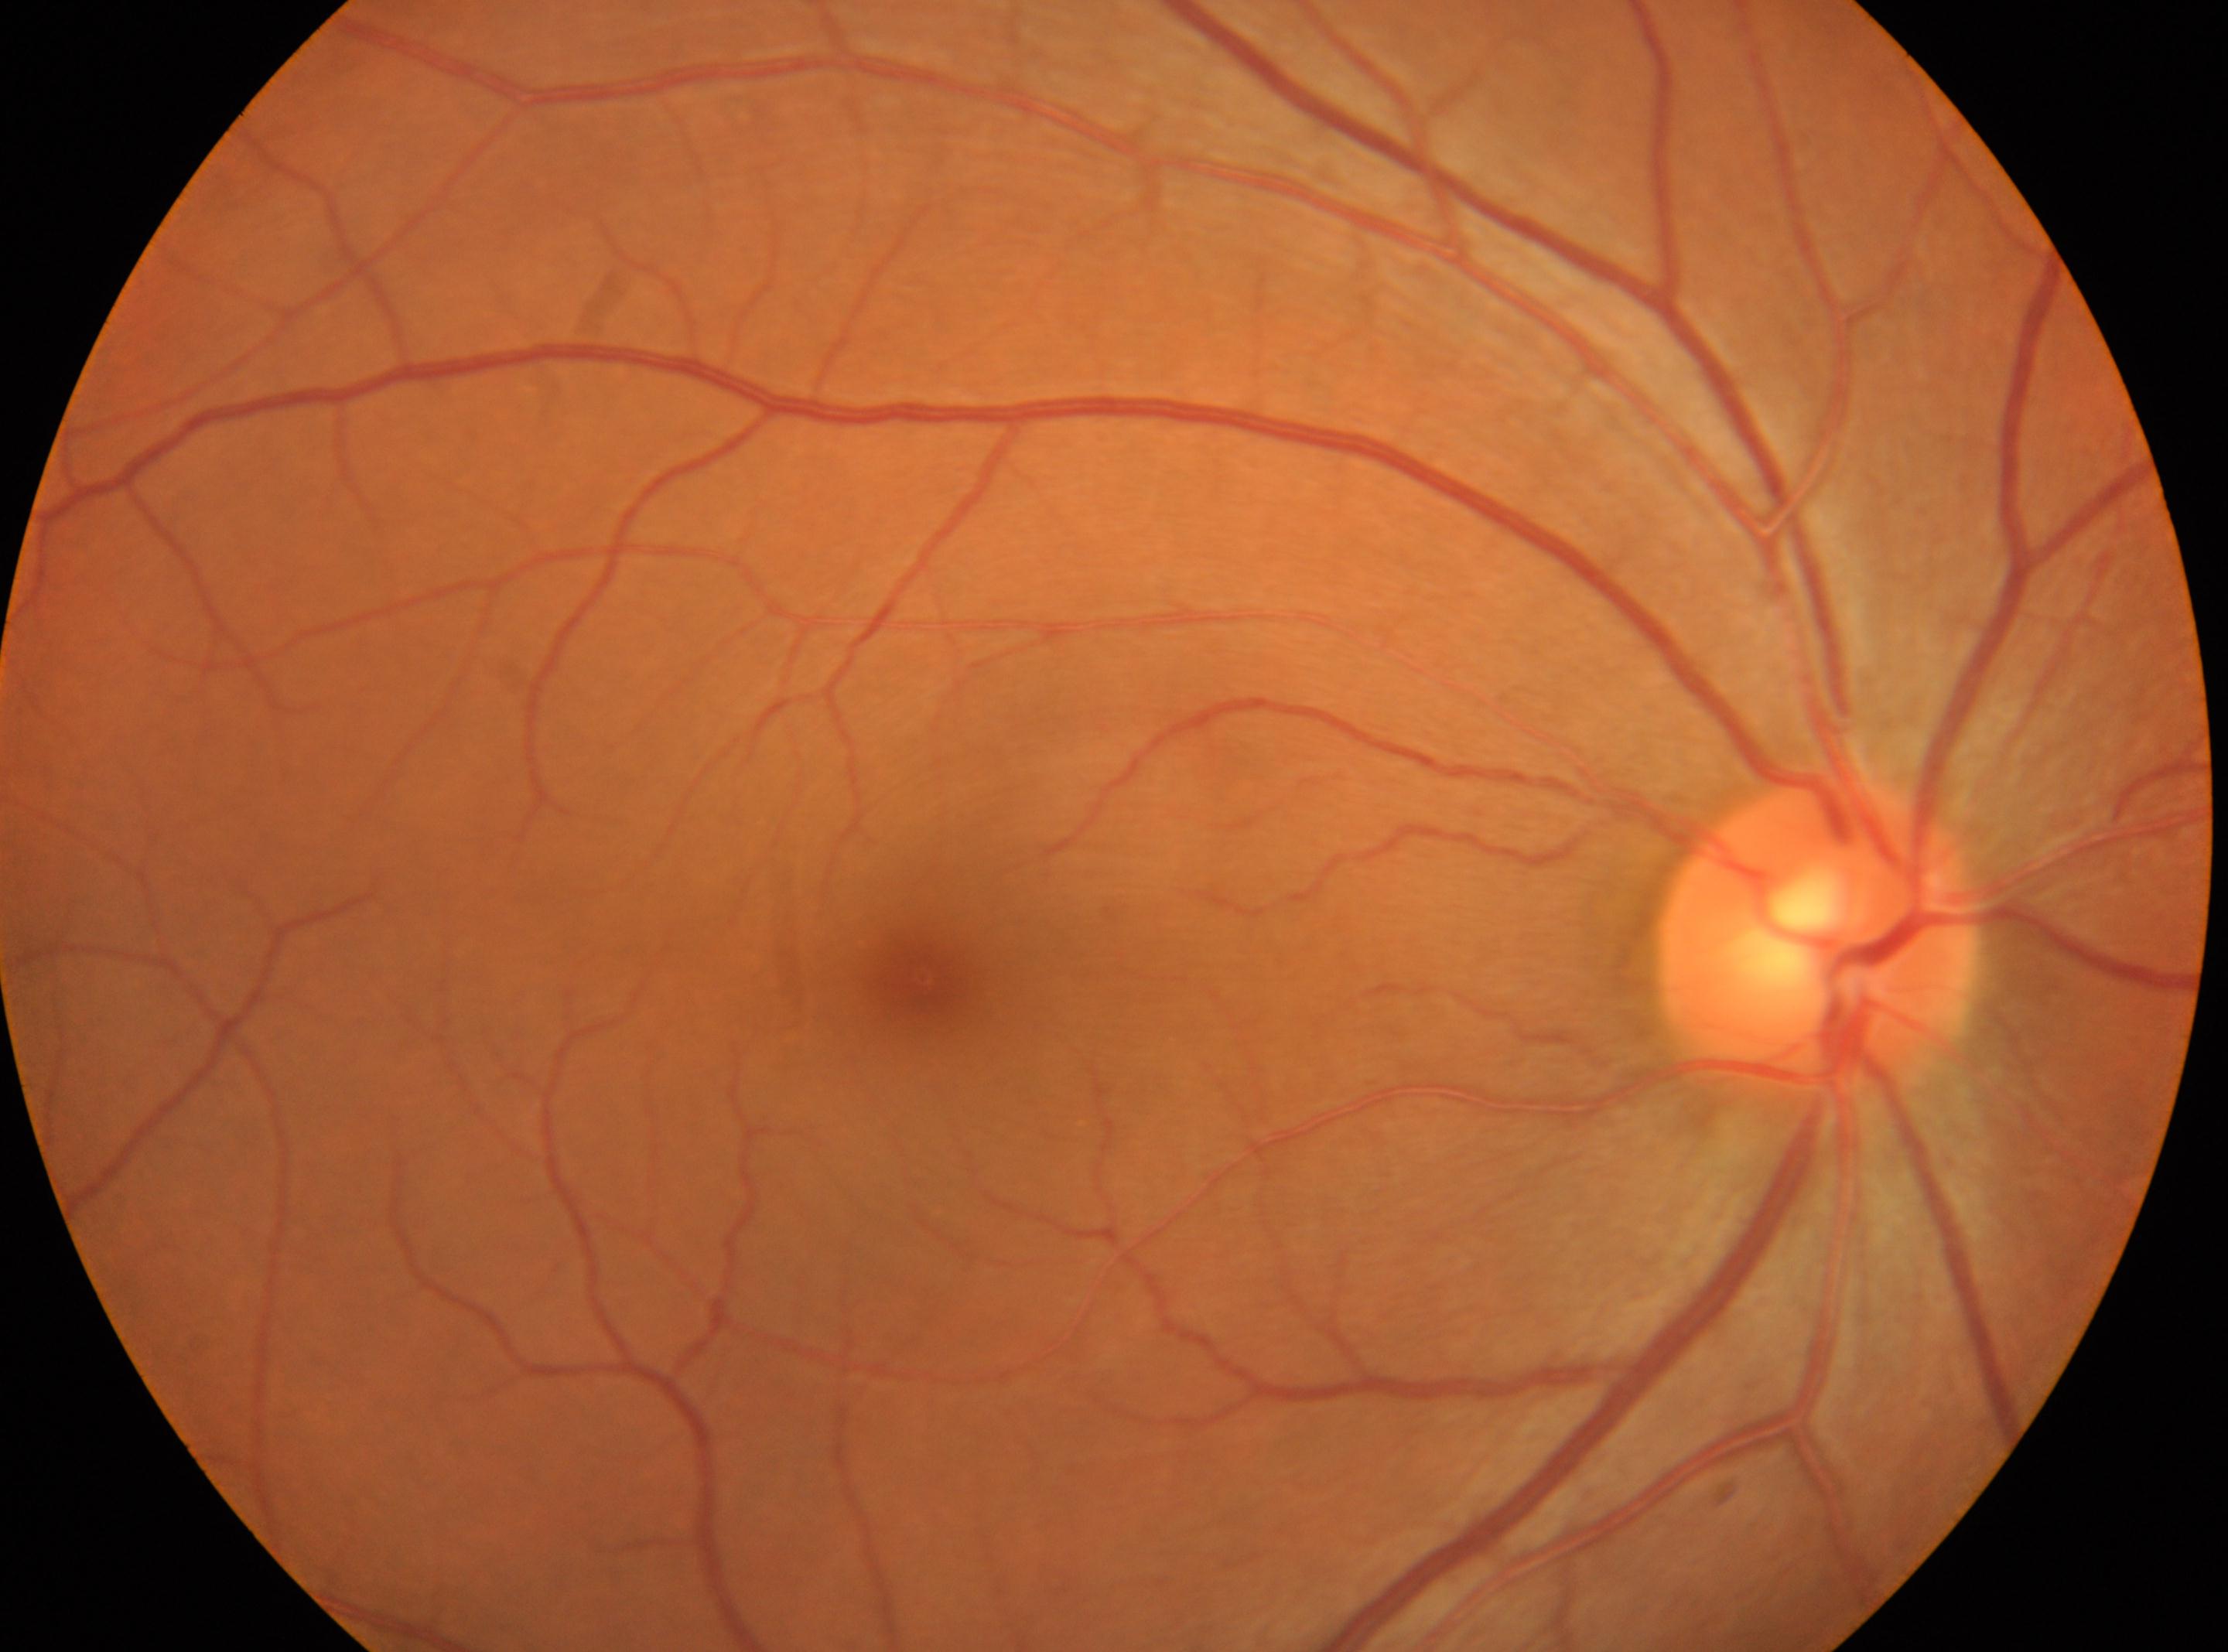 Imaged eye: OD. Foveal center: 922px, 978px. No DR findings. Optic disk located at 1816px, 939px. Retinopathy grade: 0 (no apparent retinopathy) — no visible signs of diabetic retinopathy.